Topcon TRC-NW400 · 30° field of view · image size 2212x1661 · IOP: 12 mmHg · centered on the optic disc · central corneal thickness 493 µm: 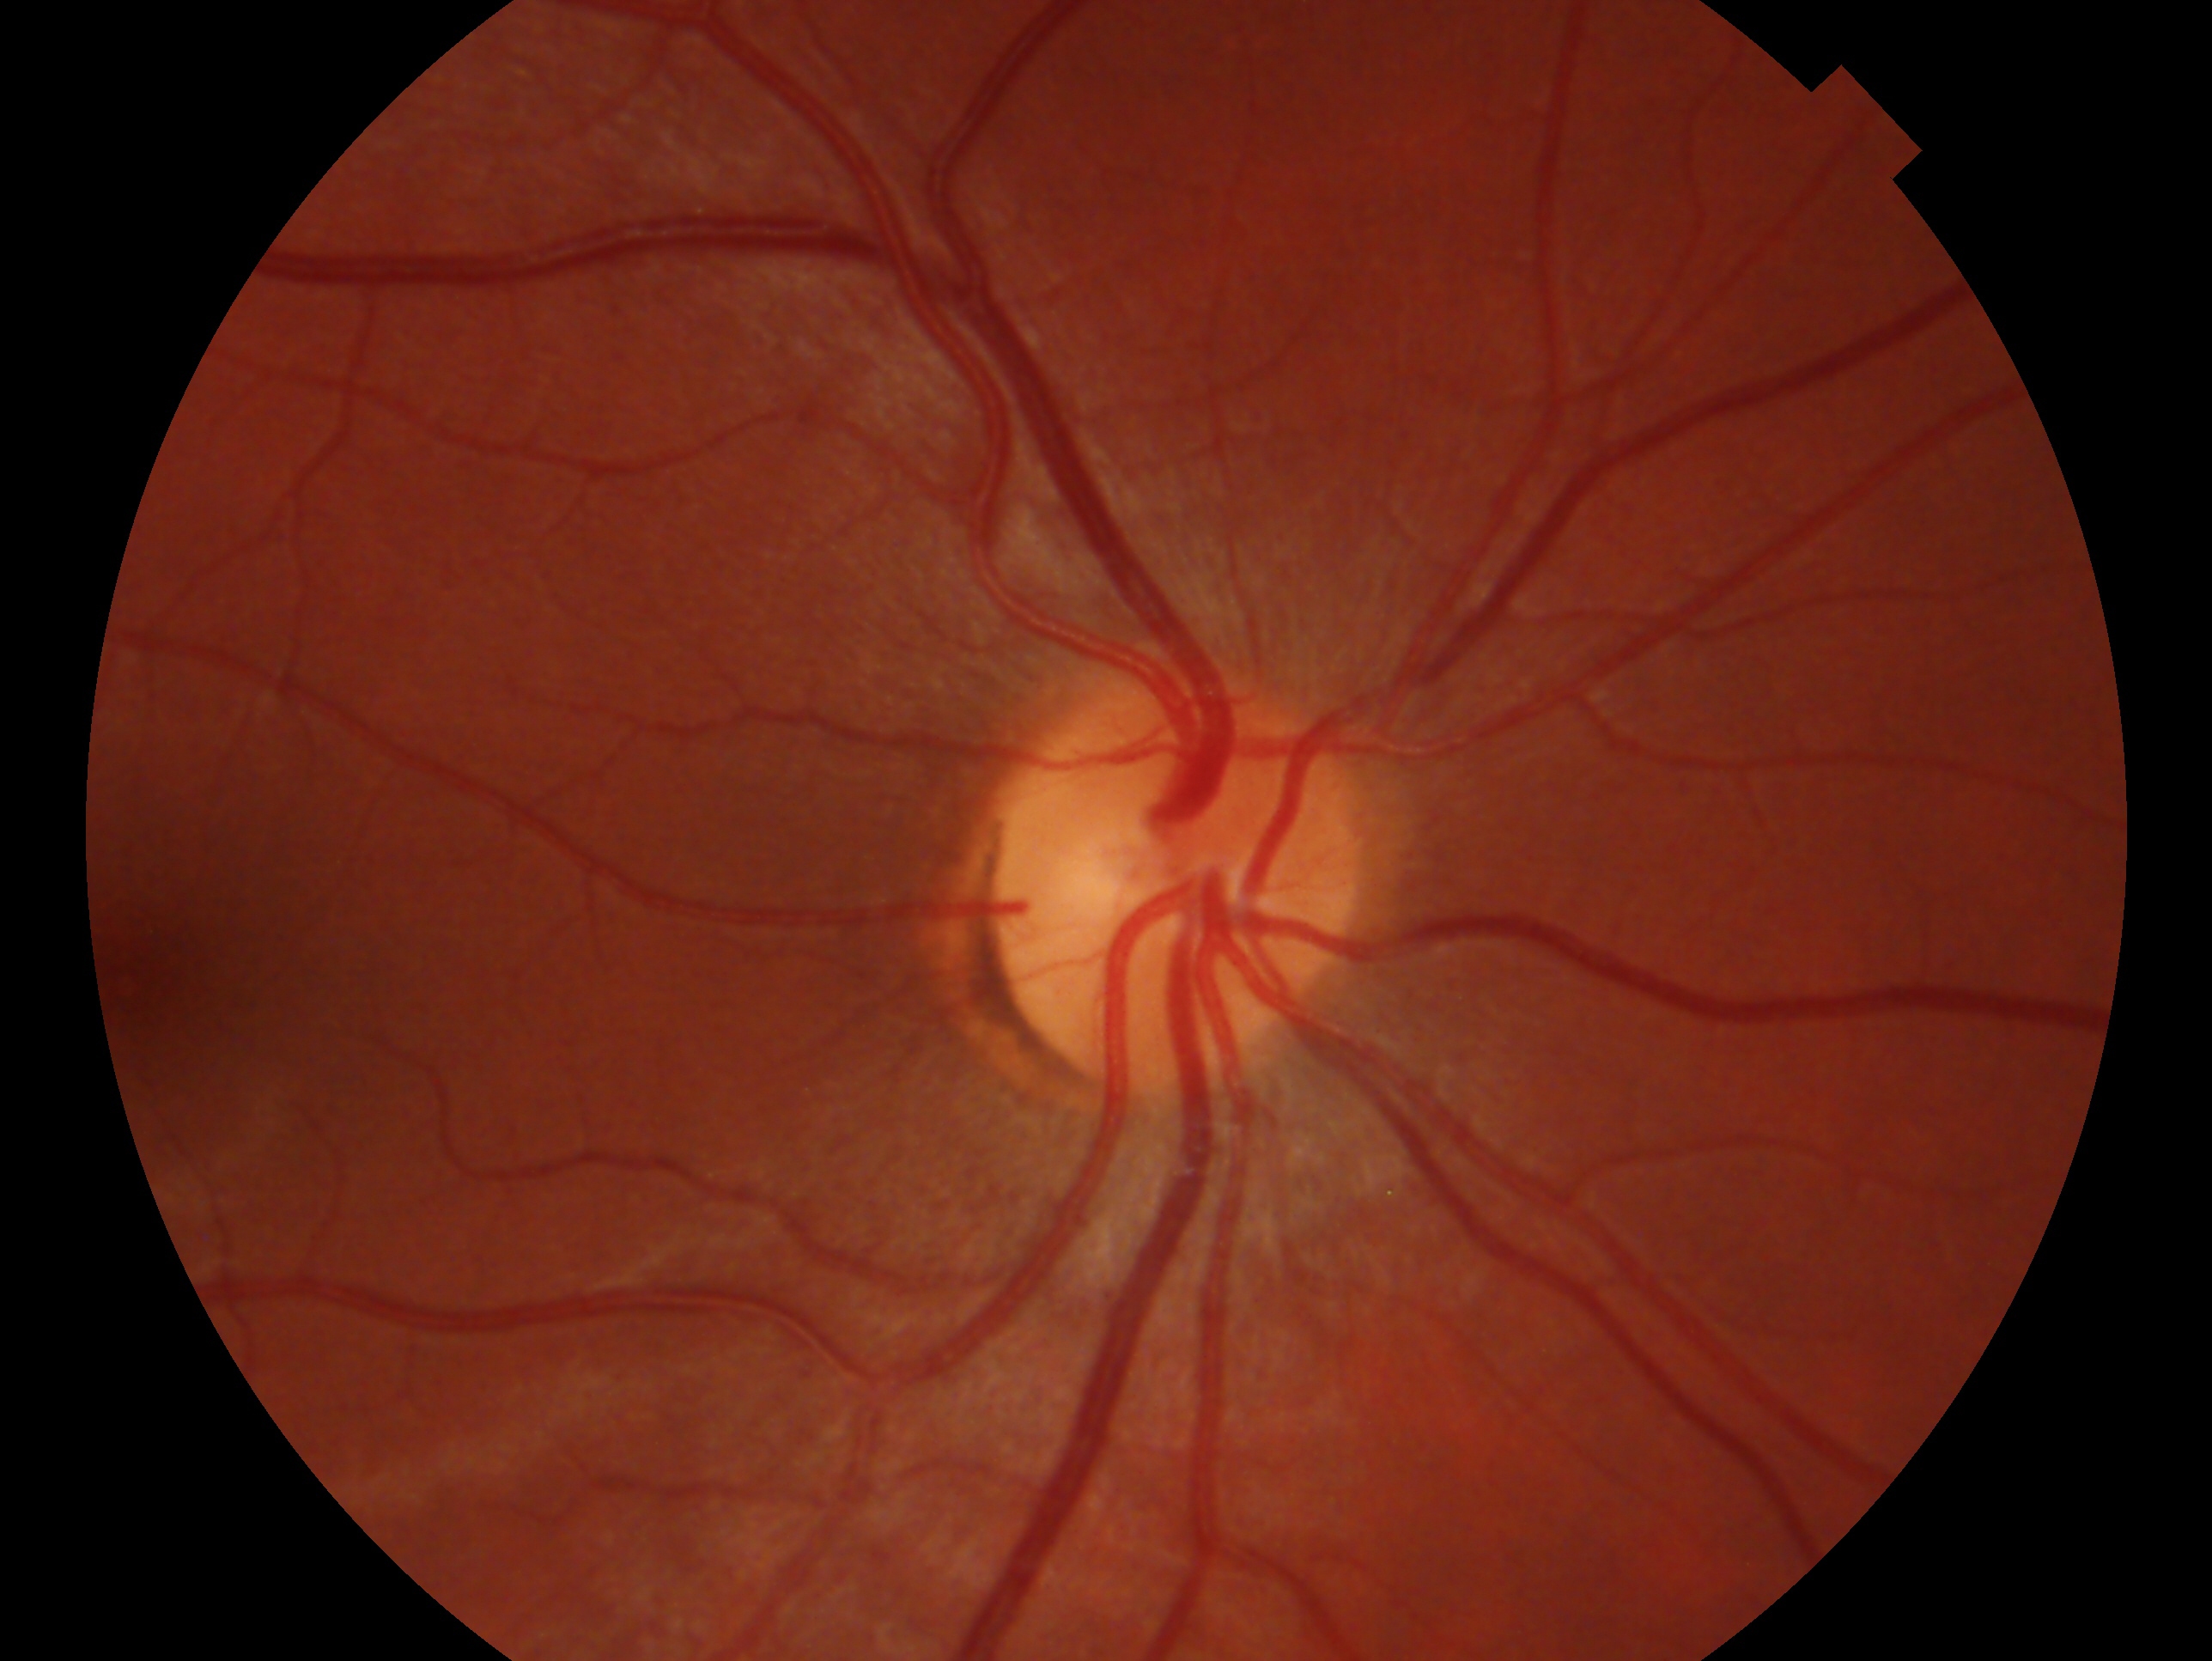
Diagnosis — no glaucoma.
This is the right eye.